Pediatric wide-field fundus photograph
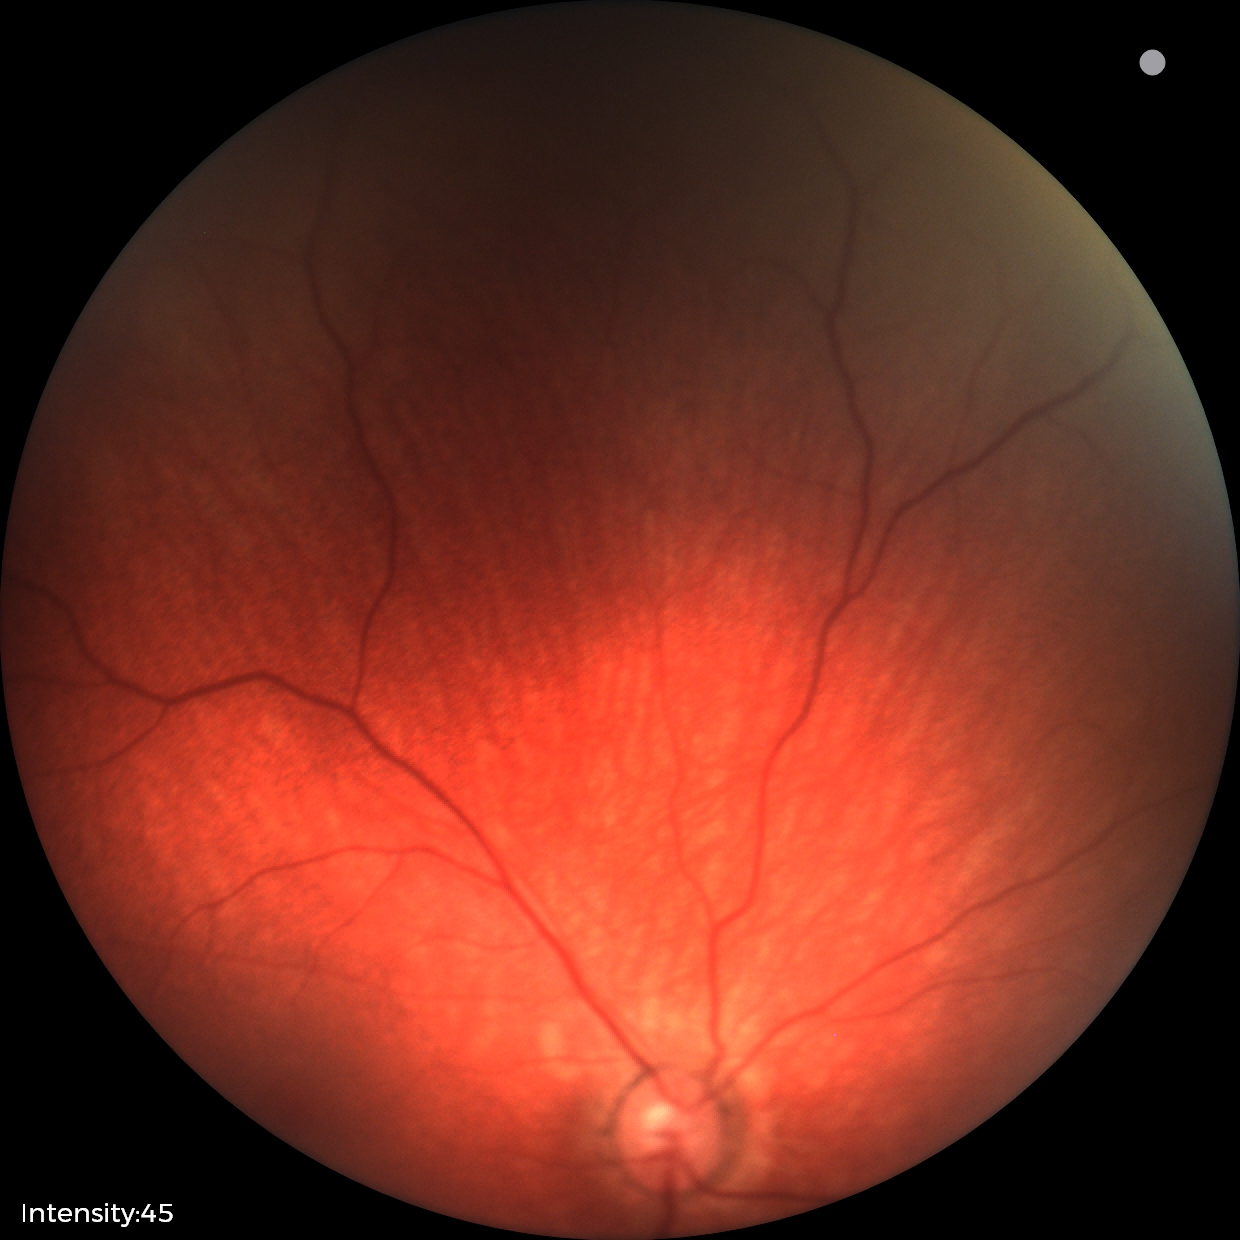 Physiological retinal appearance for postconceptual age.